Optic disc-centered crop from a color fundus photograph.
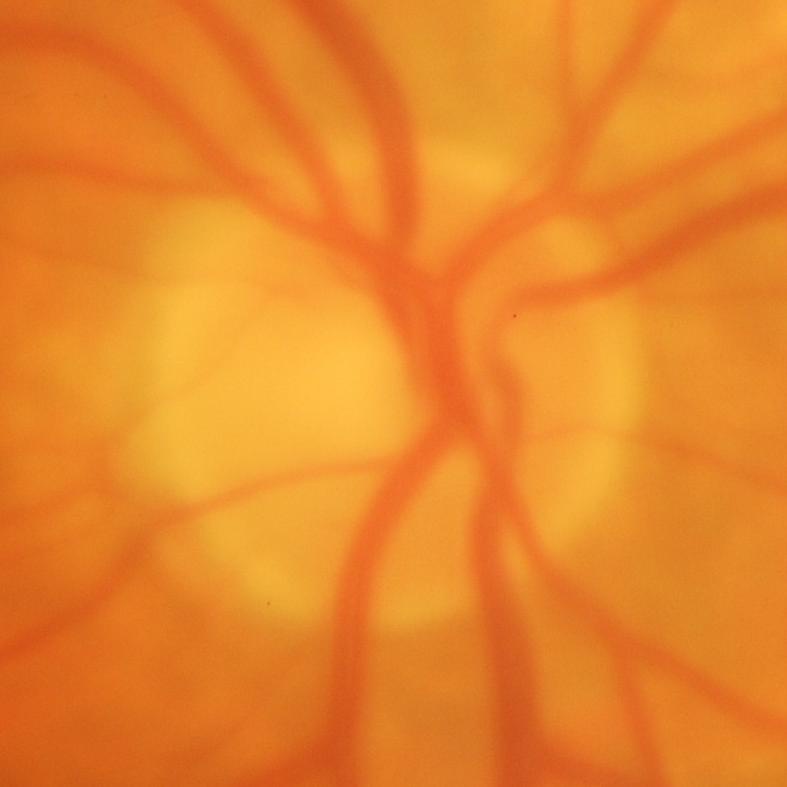

Q: Is glaucoma present?
A: Yes — glaucoma.